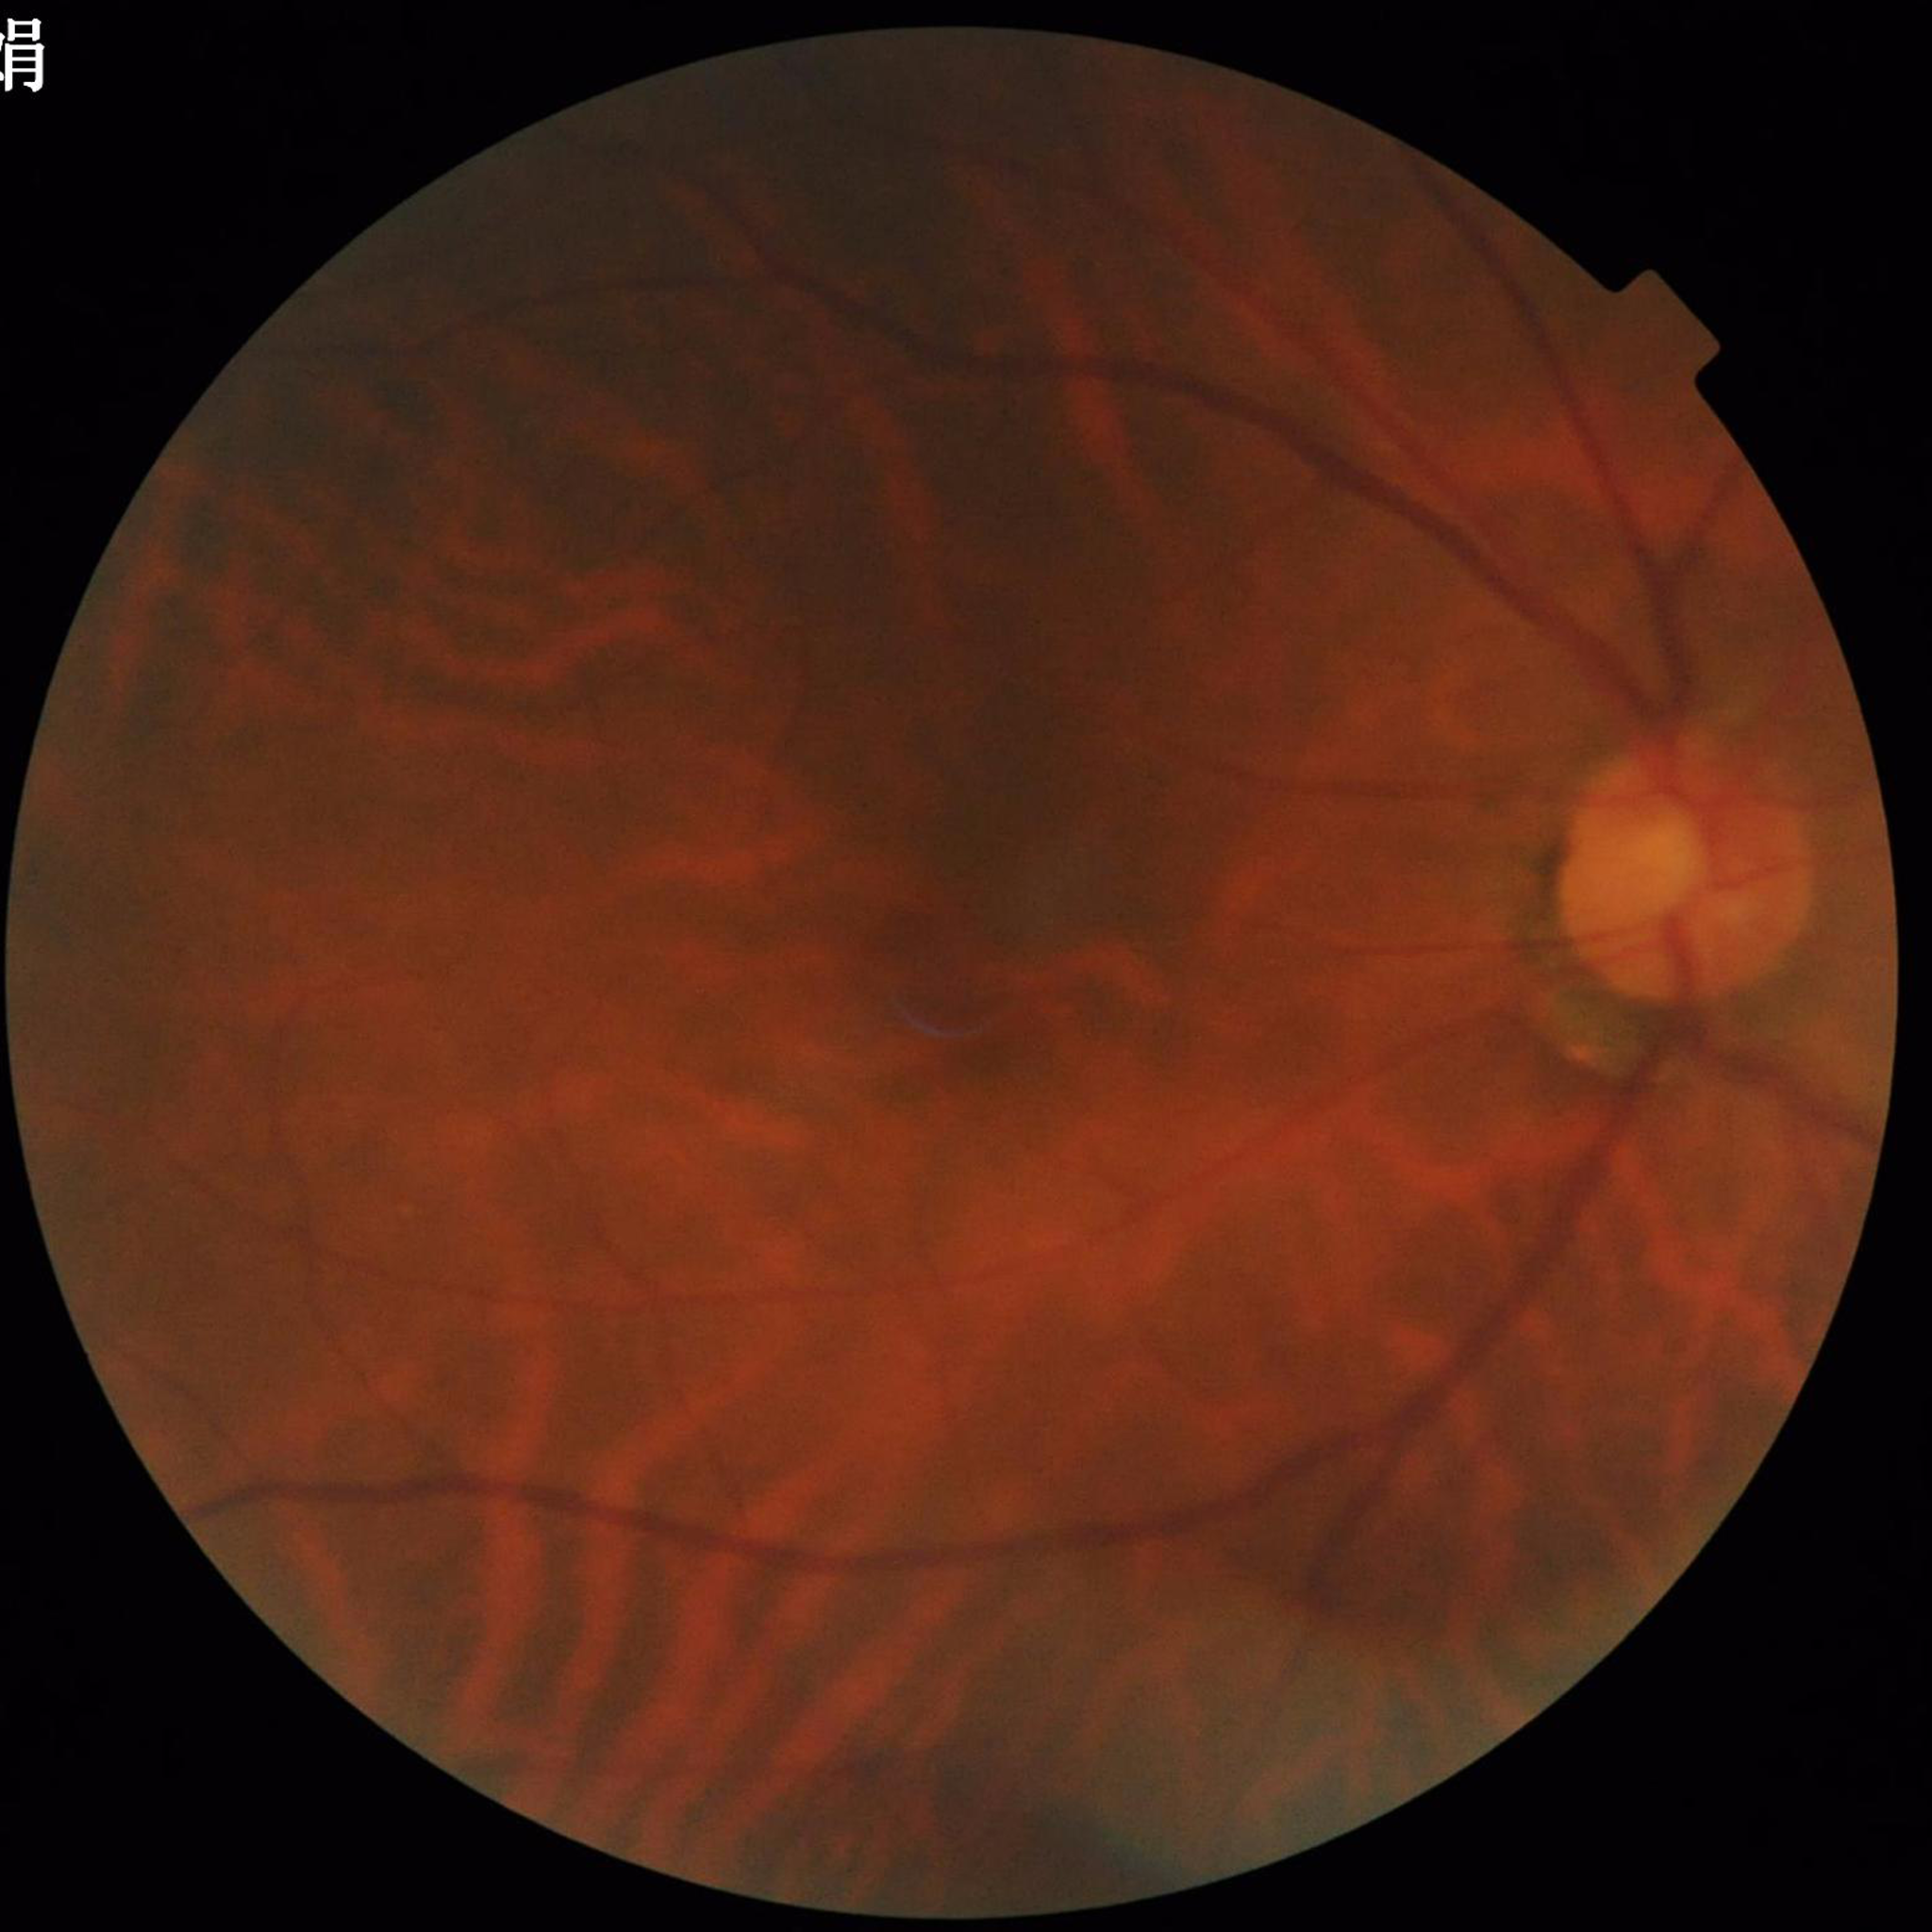

Image quality: poor — blur. The patient was diagnosed with glaucoma.